Axial length 23.82 mm; image size 2212x1661; refraction: sphere +0 D, cylinder -0.5 D, axis 19°; central corneal thickness 529 µm.
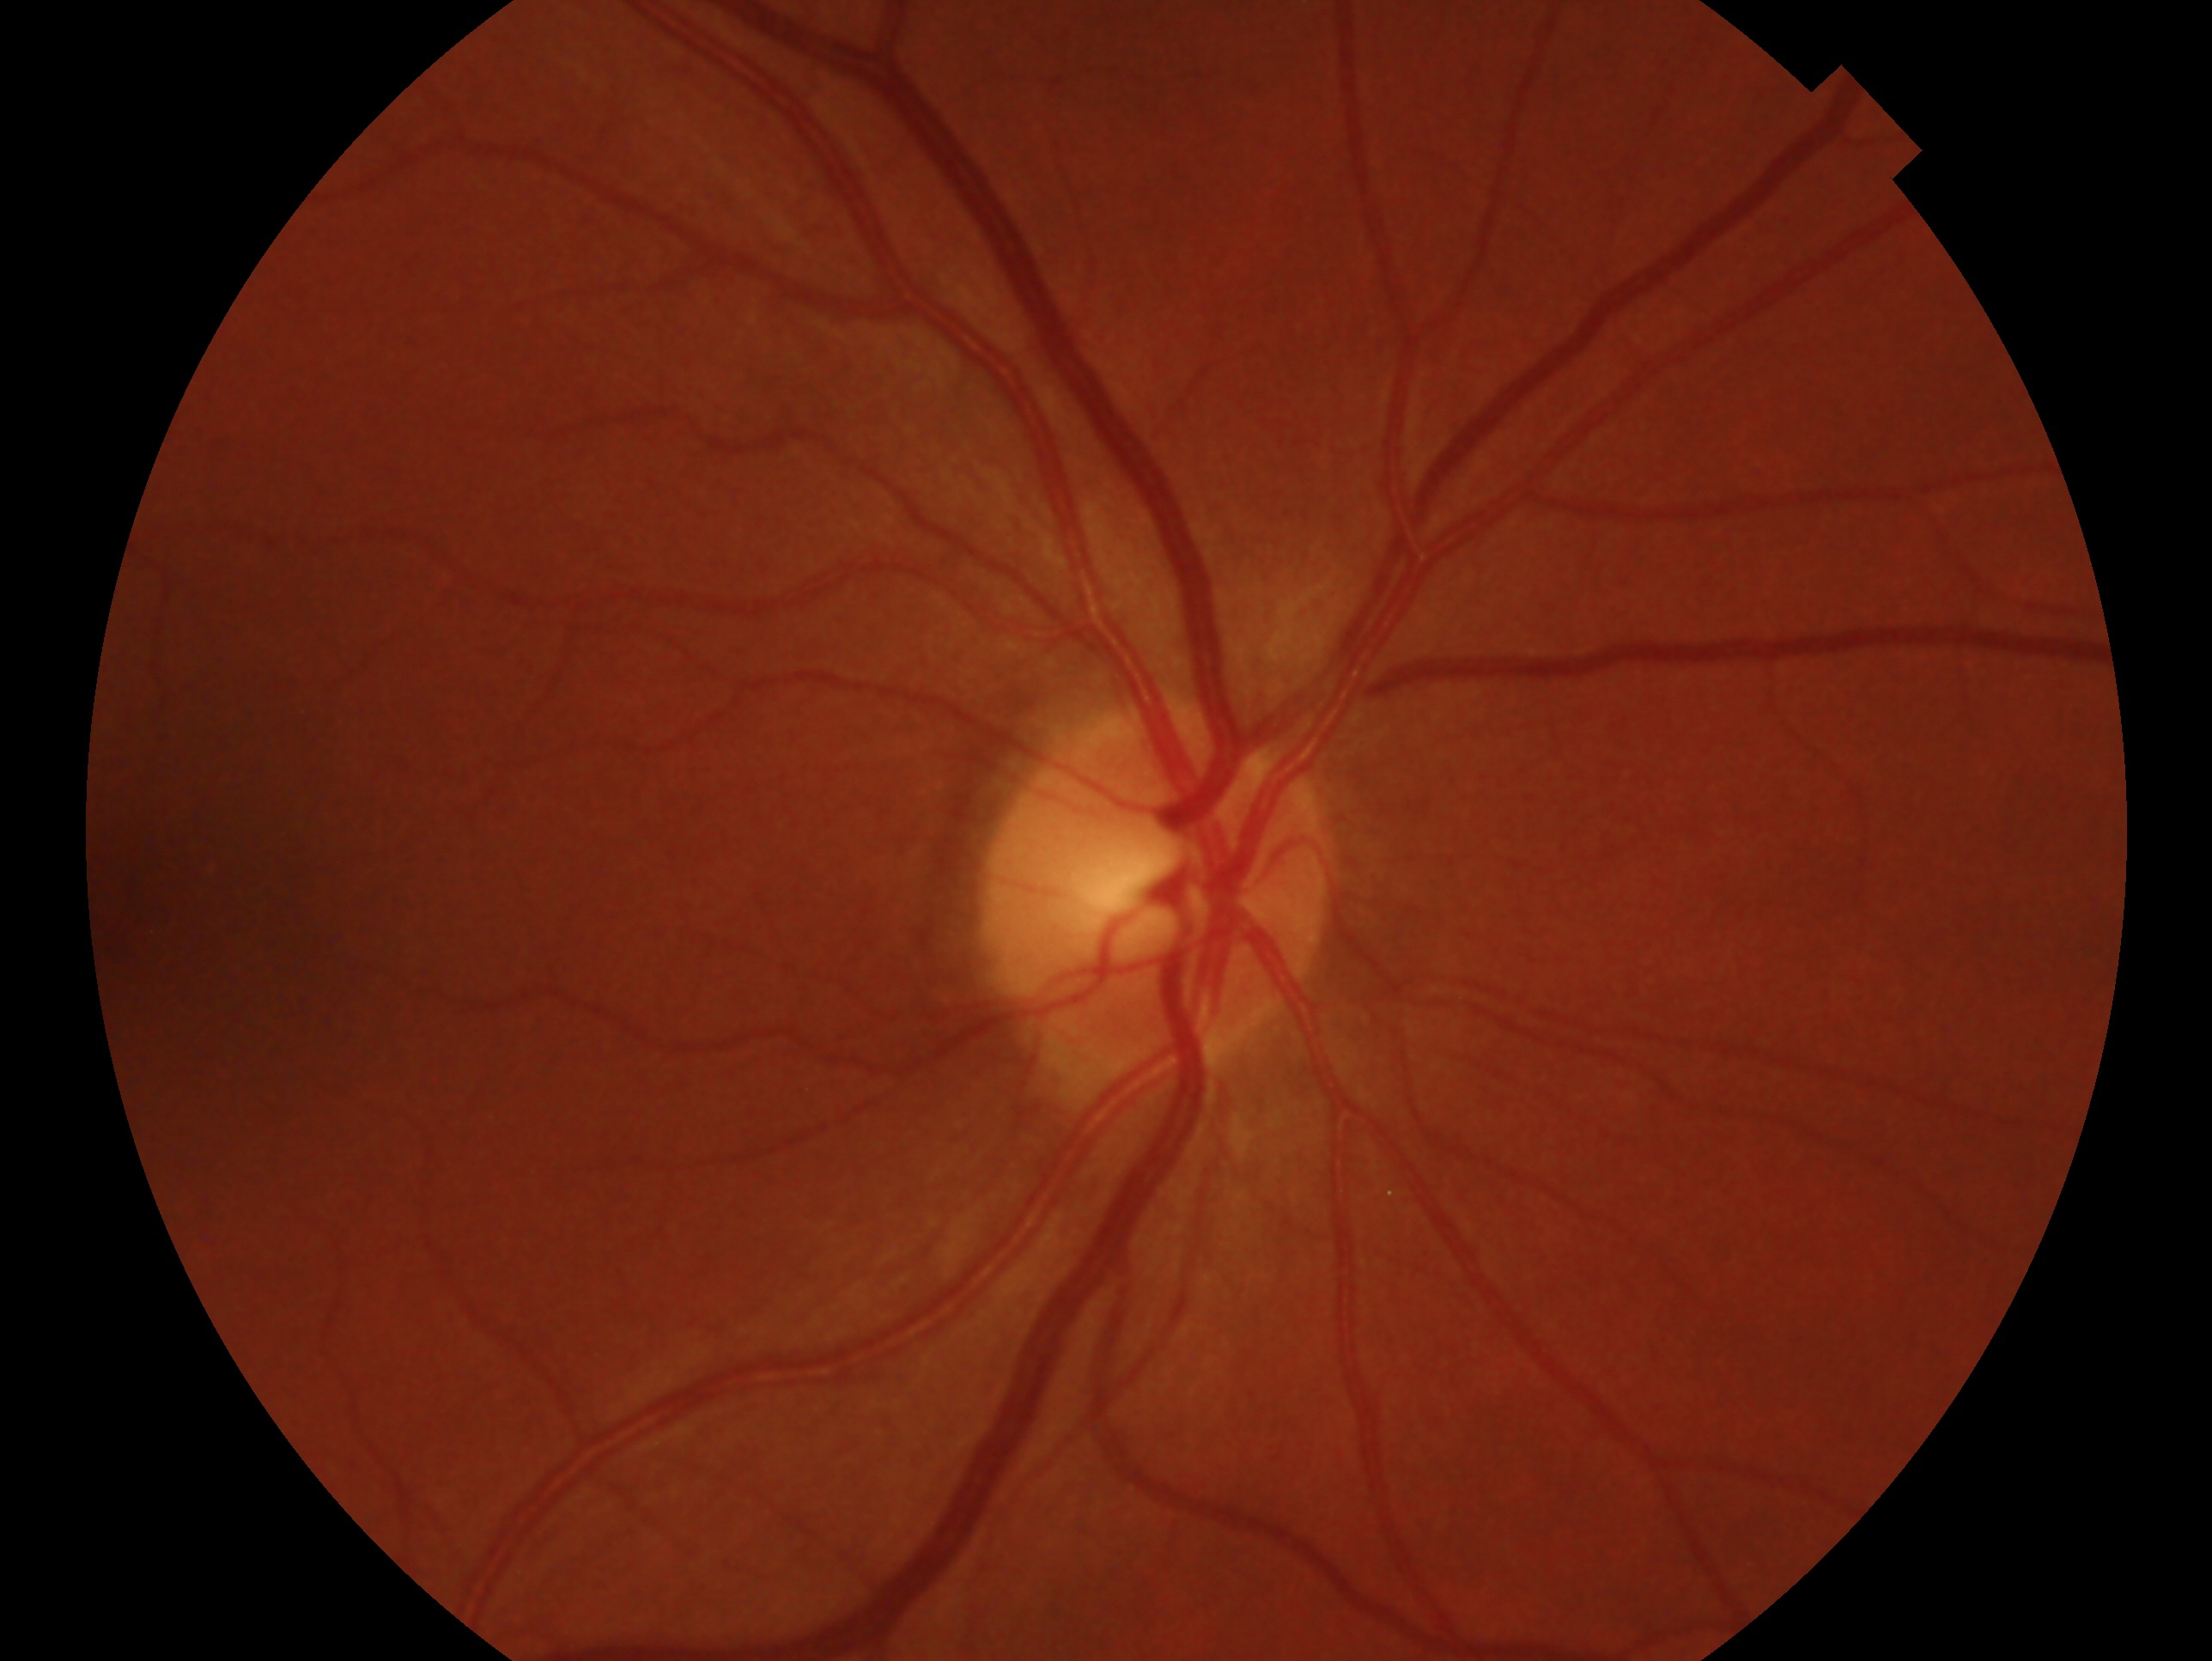
Imaged eye: right eye.
Clinical classification: no evidence of glaucoma — no clinical evidence of glaucoma in this eye.